1440 x 1080 pixels · infant wide-field fundus photograph:
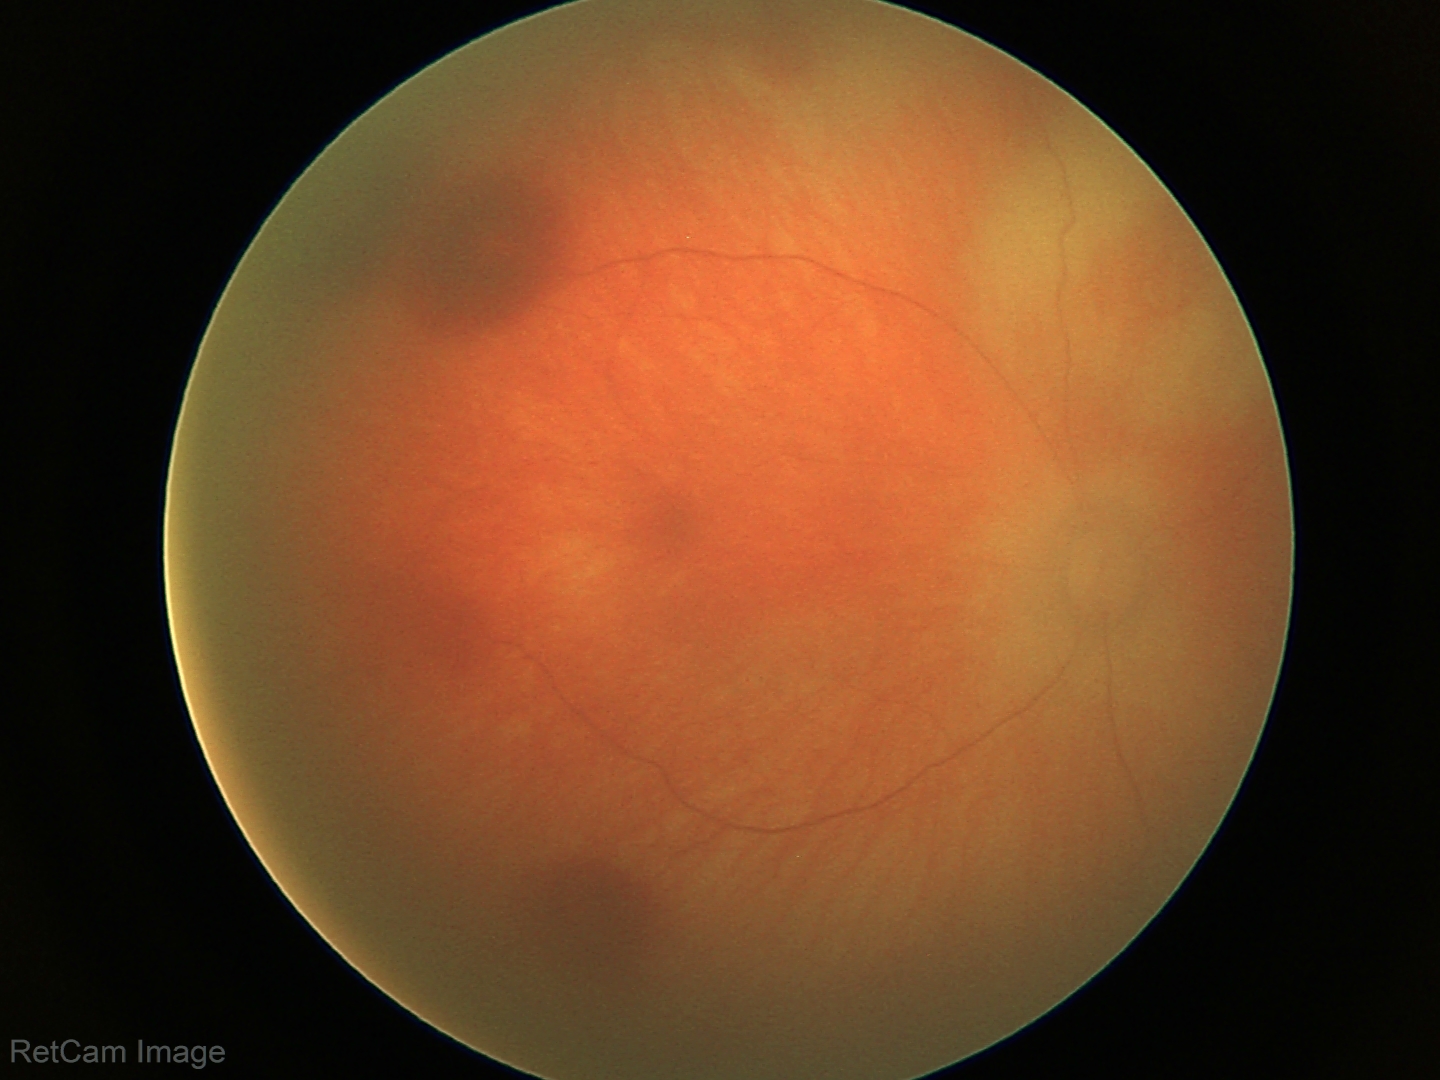 Screening examination consistent with retinal hemorrhages.